Without pupil dilation. Image size 848x848. 45 degree fundus photograph. Color fundus photograph:
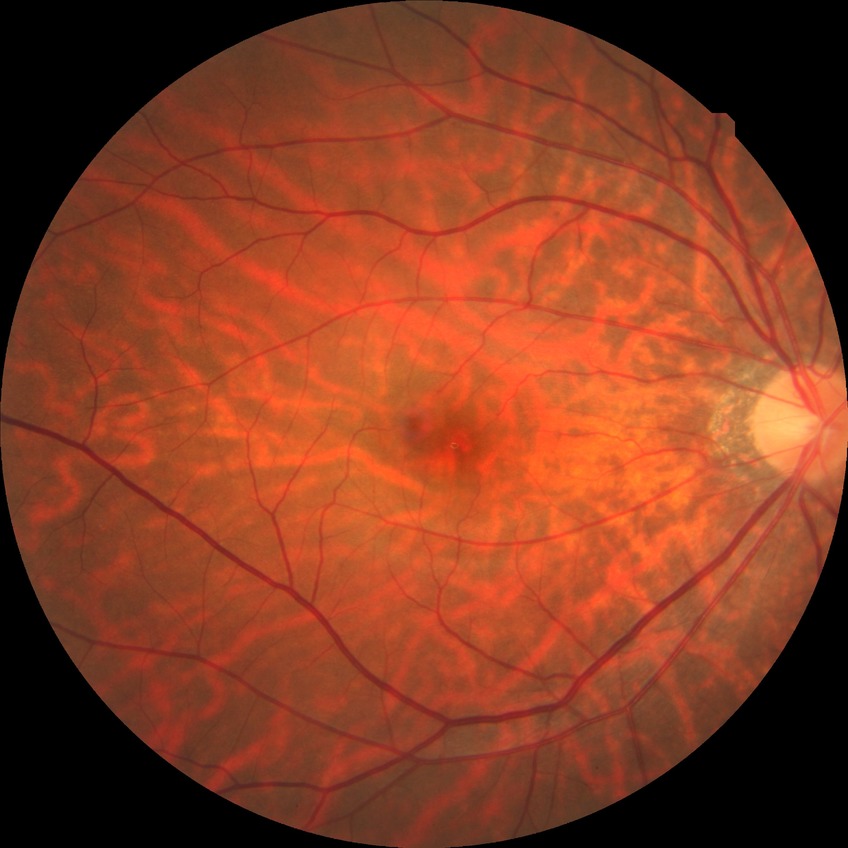
Diabetic retinopathy (DR): no diabetic retinopathy (NDR).